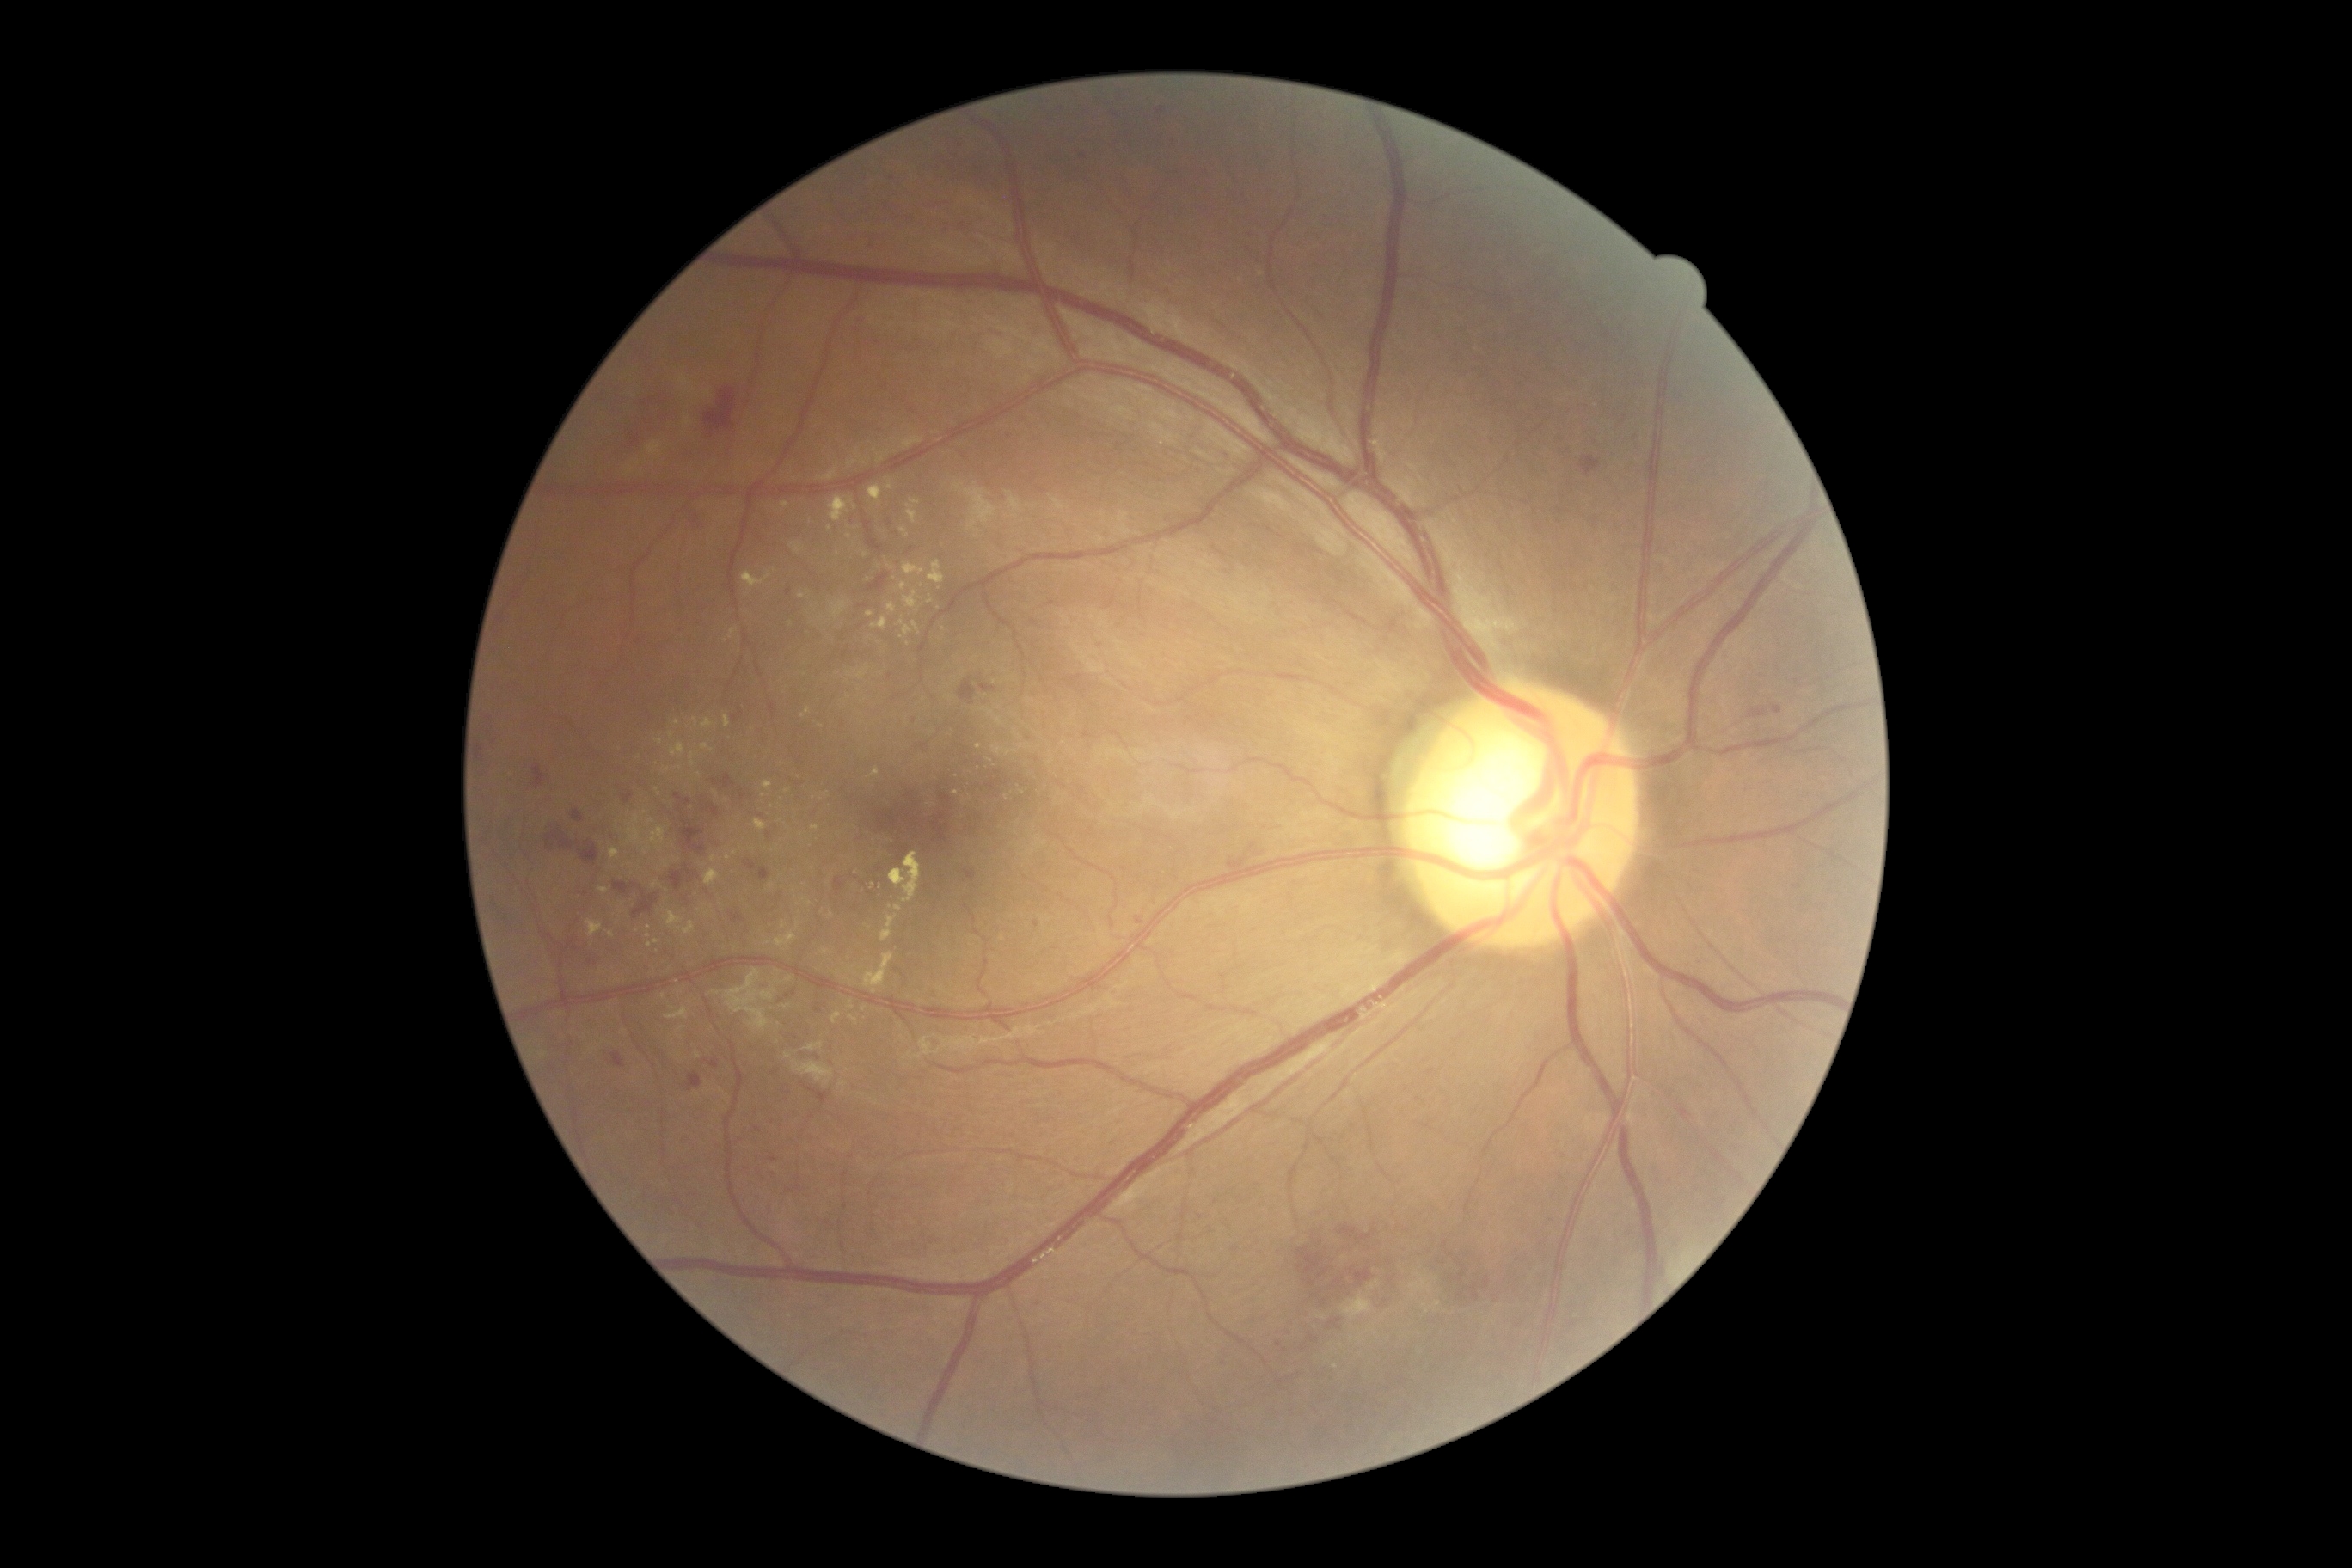 Diabetic retinopathy grade is 2/4 — more than just microaneurysms but less than severe NPDR. Hard exudates include lesions at [609,848,620,861], [797,922,800,931], [857,666,871,680], [888,603,897,615], [690,754,695,768], [888,481,893,491], [867,486,883,503], [644,826,666,855], [776,933,797,948], [812,826,821,831]. Additional small hard exudates near pt(699, 775), pt(716, 794), pt(773, 886), pt(618, 981), pt(787, 791), pt(649, 927), pt(808, 904).